2352x1568px.
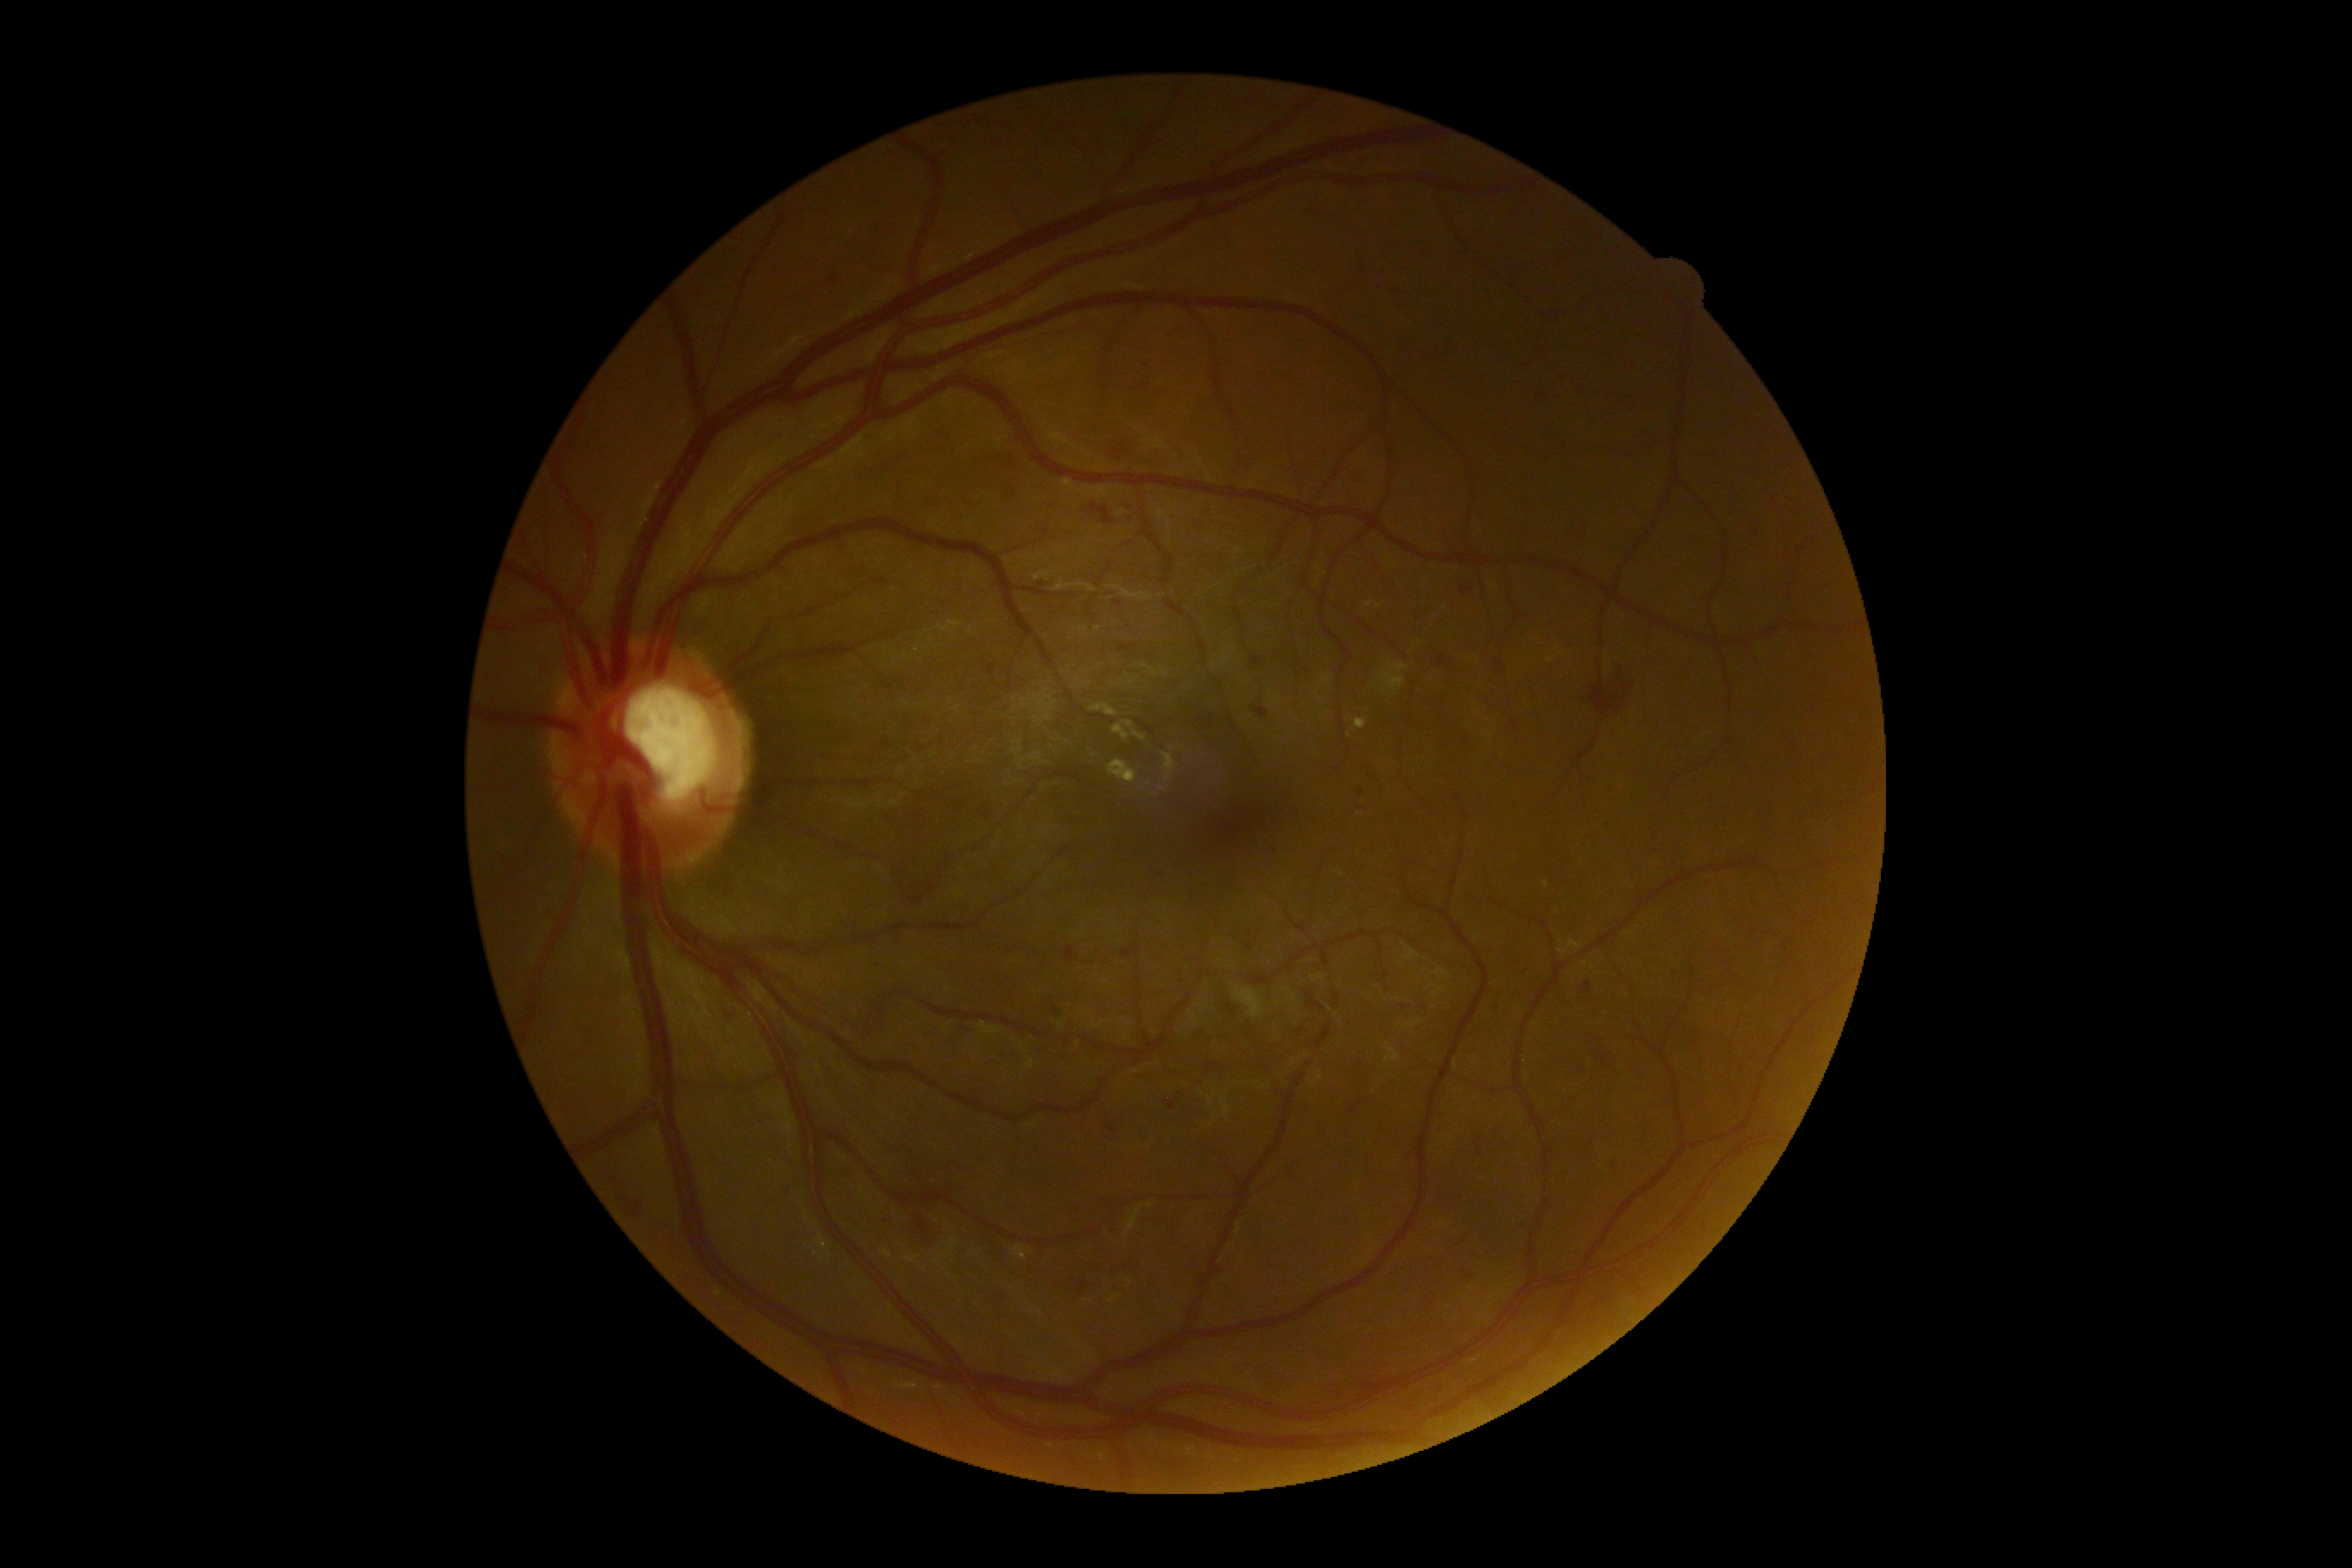
Diabetic retinopathy: moderate non-proliferative diabetic retinopathy (grade 2).
Hemorrhages are present, including at {"left": 838, "top": 1167, "right": 855, "bottom": 1182} | {"left": 1122, "top": 946, "right": 1142, "bottom": 959} | {"left": 1204, "top": 1063, "right": 1220, "bottom": 1072} | {"left": 878, "top": 775, "right": 979, "bottom": 902} | {"left": 1356, "top": 790, "right": 1364, "bottom": 797} | {"left": 879, "top": 740, "right": 891, "bottom": 749} | {"left": 1560, "top": 639, "right": 1576, "bottom": 651} | {"left": 1608, "top": 1158, "right": 1624, "bottom": 1185} | {"left": 1072, "top": 1278, "right": 1093, "bottom": 1295} | {"left": 1065, "top": 948, "right": 1079, "bottom": 964} | {"left": 1436, "top": 656, "right": 1450, "bottom": 670} | {"left": 1110, "top": 1261, "right": 1144, "bottom": 1280} | {"left": 986, "top": 665, "right": 996, "bottom": 673}.
Hemorrhages (small, approximate centers) near {"x": 1403, "y": 1007} | {"x": 1360, "y": 809} | {"x": 1275, "y": 852}.
Hard exudates are present, including at {"left": 1567, "top": 940, "right": 1581, "bottom": 948} | {"left": 1034, "top": 572, "right": 1051, "bottom": 582} | {"left": 1108, "top": 759, "right": 1137, "bottom": 783} | {"left": 1113, "top": 725, "right": 1130, "bottom": 742} | {"left": 1062, "top": 479, "right": 1072, "bottom": 487} | {"left": 818, "top": 1237, "right": 828, "bottom": 1253} | {"left": 1014, "top": 1246, "right": 1027, "bottom": 1261} | {"left": 1124, "top": 721, "right": 1134, "bottom": 730} | {"left": 1134, "top": 732, "right": 1146, "bottom": 742} | {"left": 1559, "top": 948, "right": 1567, "bottom": 955} | {"left": 1356, "top": 720, "right": 1368, "bottom": 730}.
Hard exudates (small, approximate centers) near {"x": 816, "y": 1254} | {"x": 1321, "y": 1078} | {"x": 1545, "y": 885}.
No soft exudates identified.
No microaneurysms identified.